2212x1659px, 45-degree field of view: 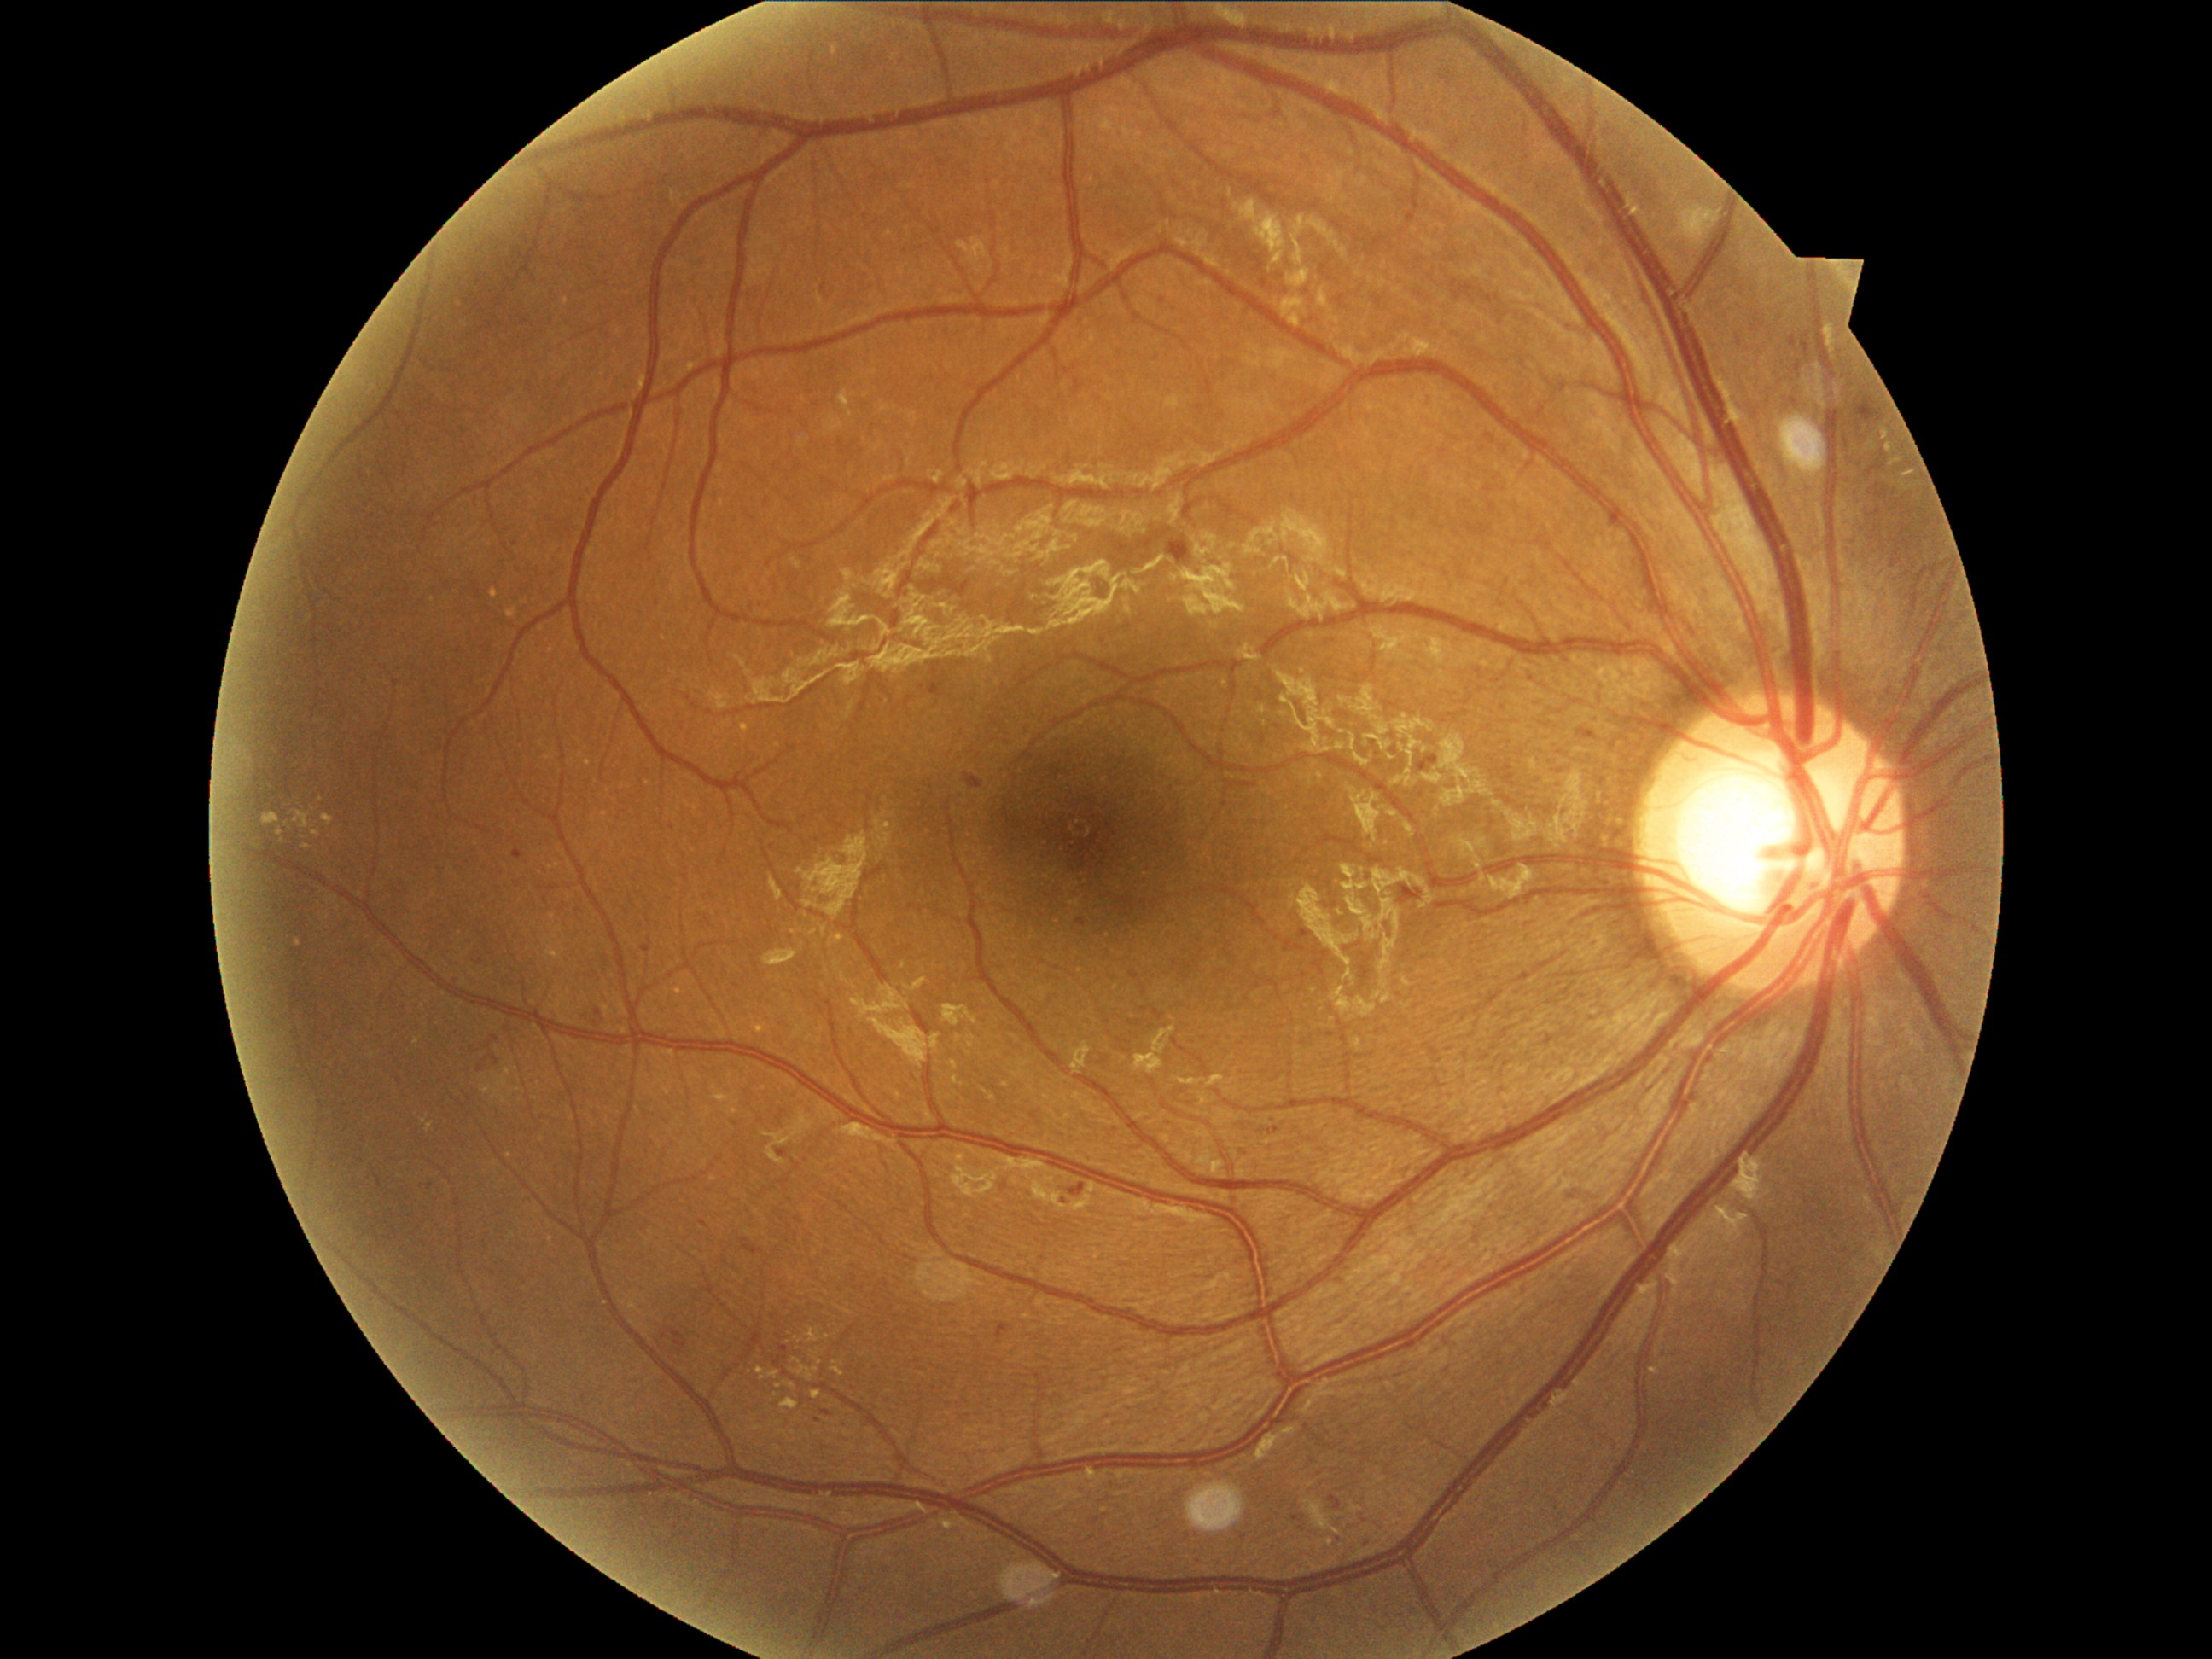

DR class = non-proliferative diabetic retinopathy
DR severity = 2